Camera: Phoenix ICON (100° FOV). 1240x1240. Wide-field fundus image from infant ROP screening — 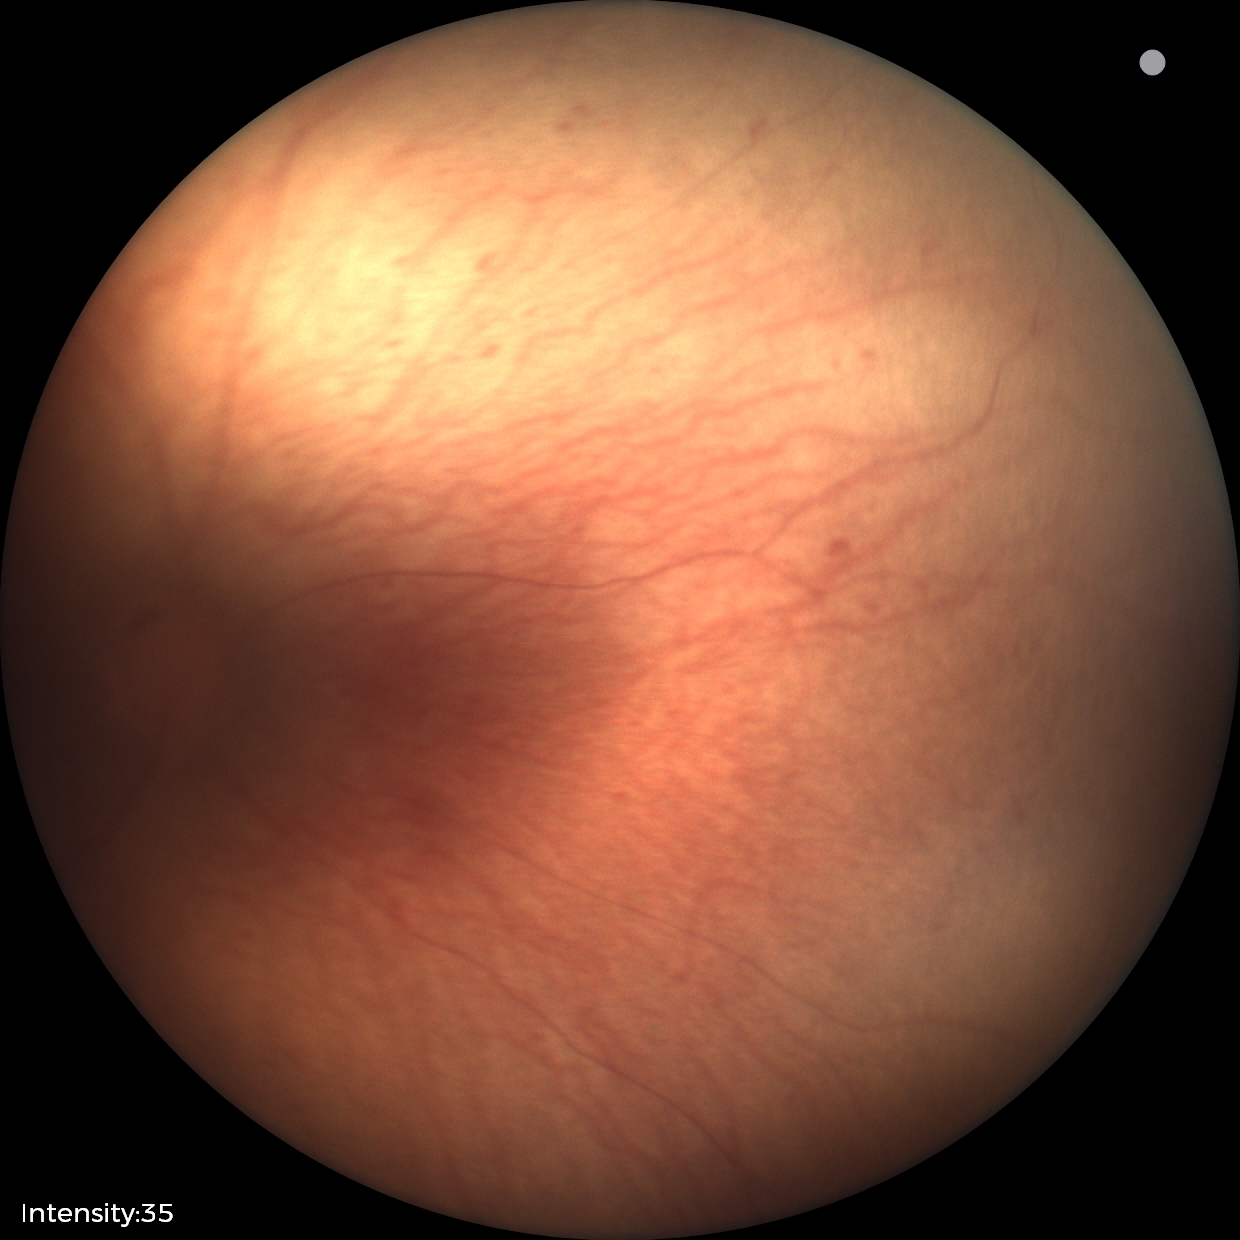

No plus disease. Series diagnosed as ROP stage 1 — demarcation line between vascular and avascular retina.